Color fundus photograph. 2048 by 1536 pixels. 45° FOV
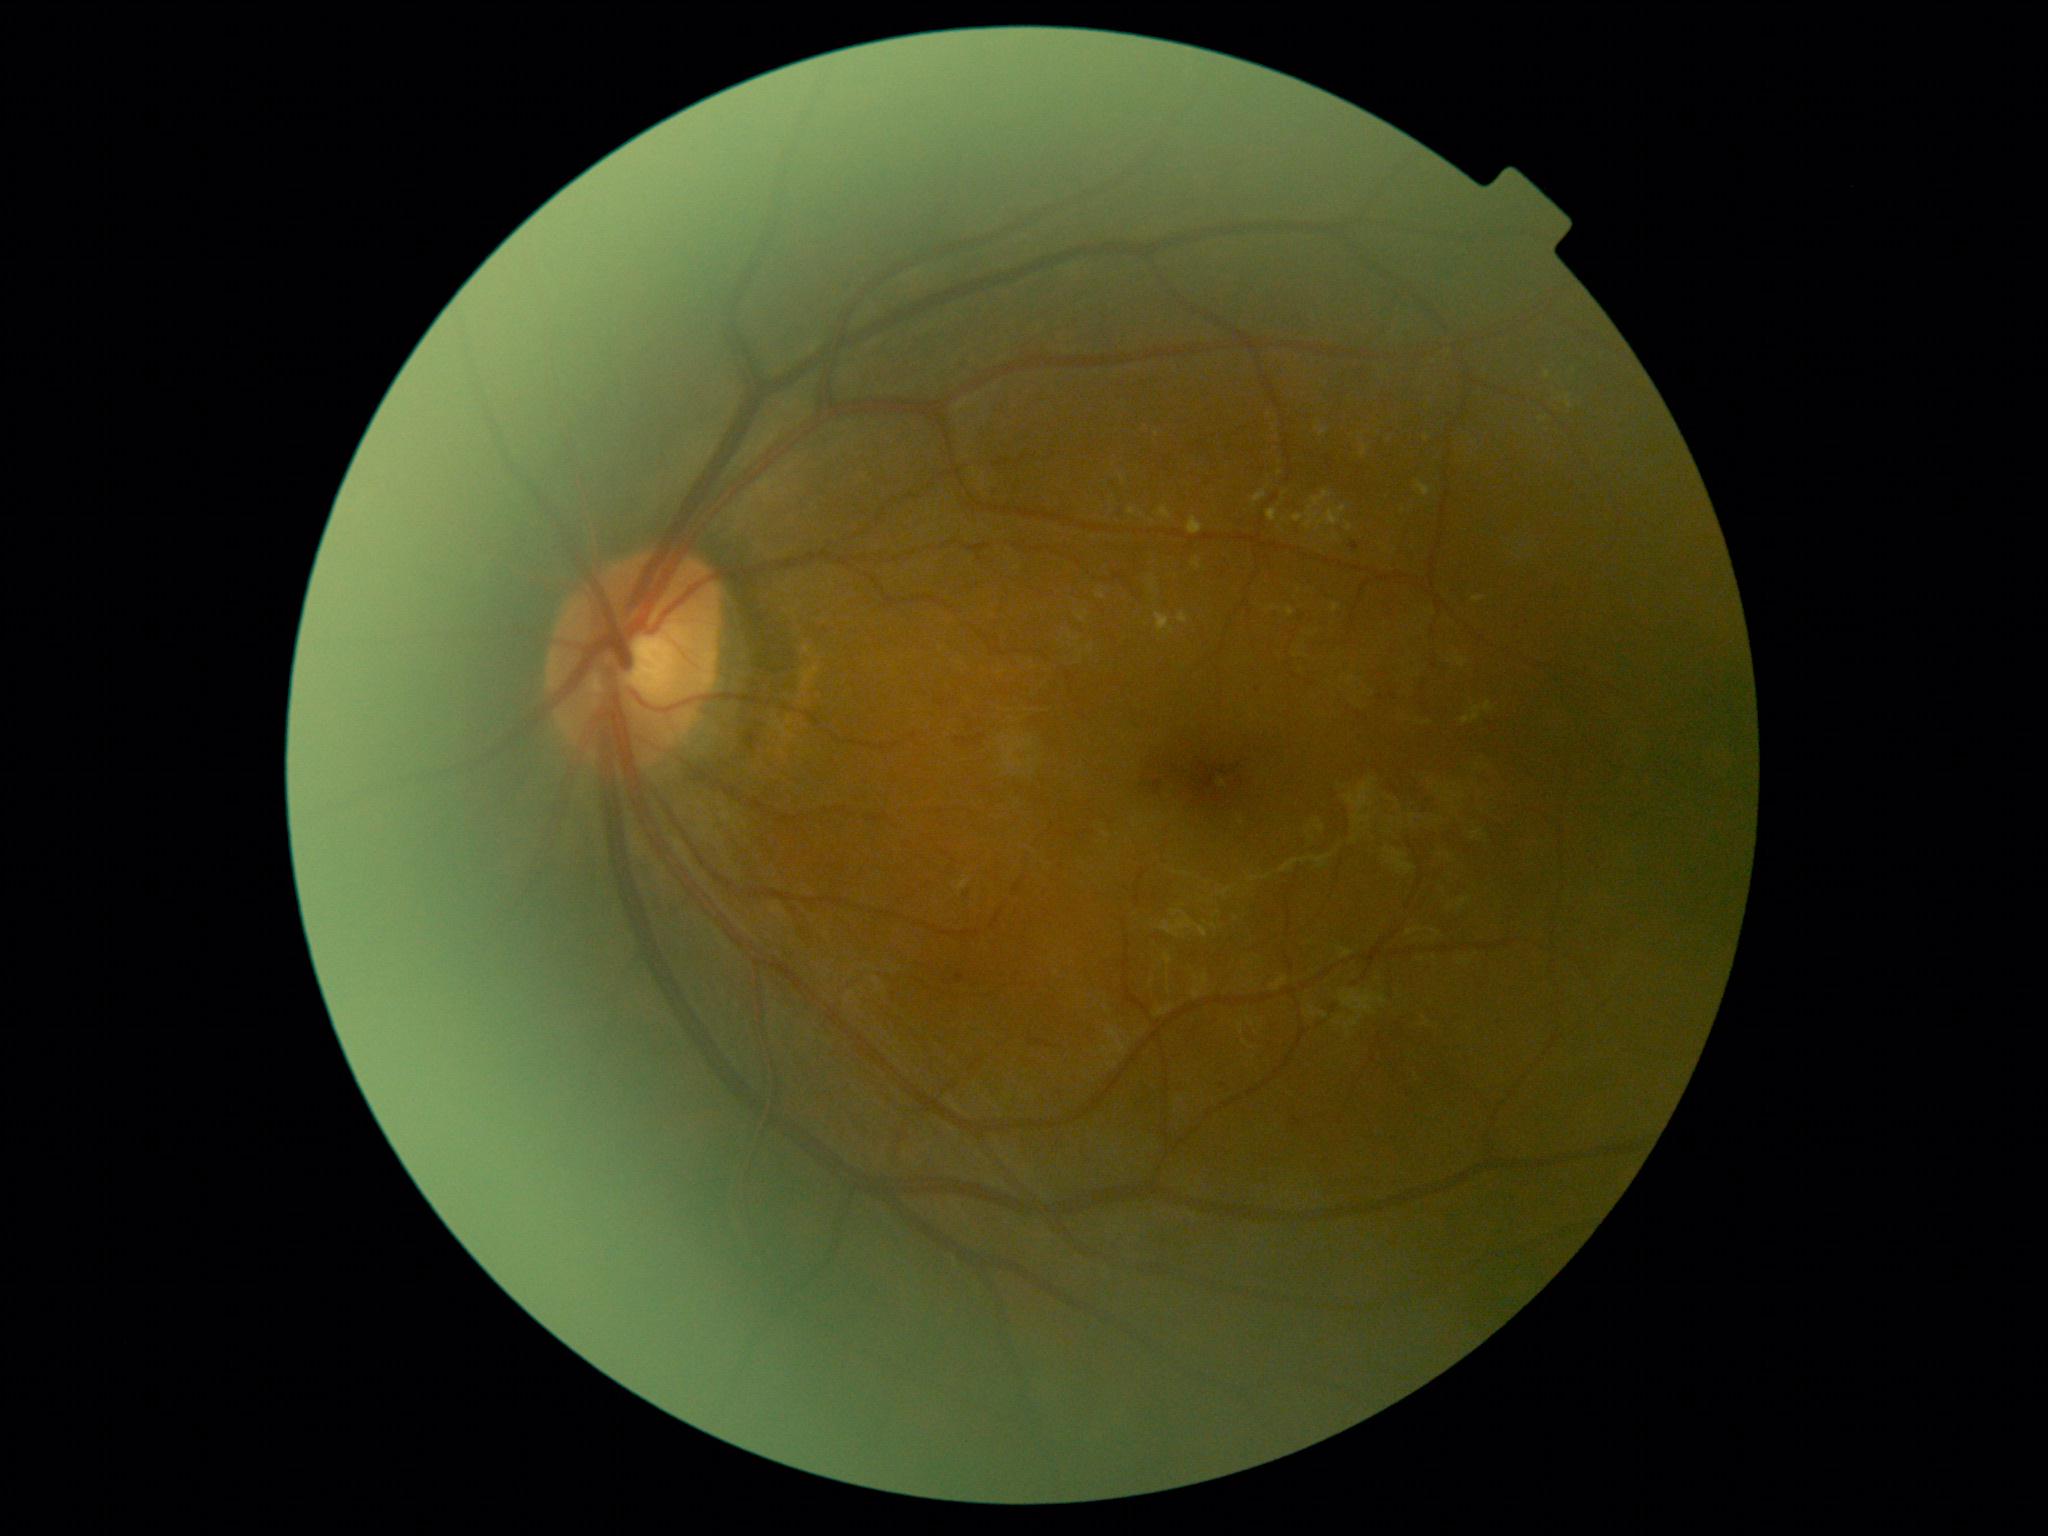

diabetic retinopathy (DR) = 2.